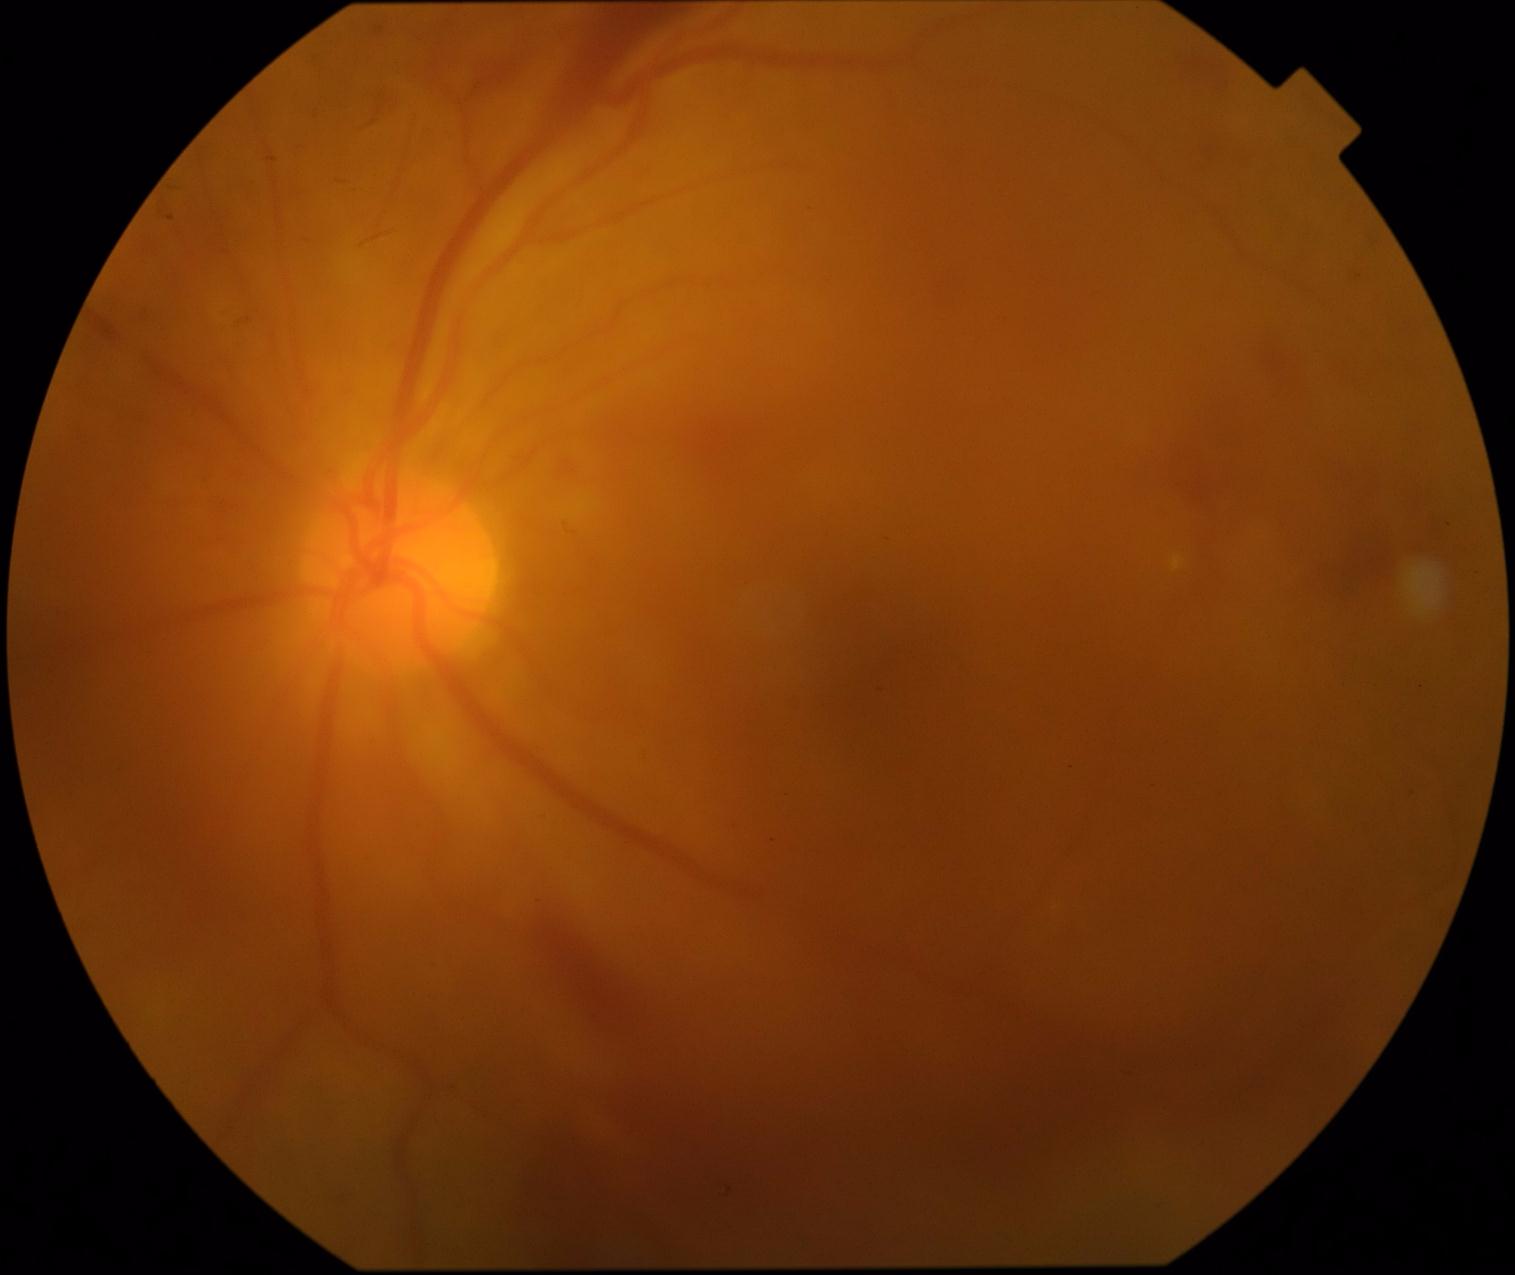

Retinopathy is grade 4.